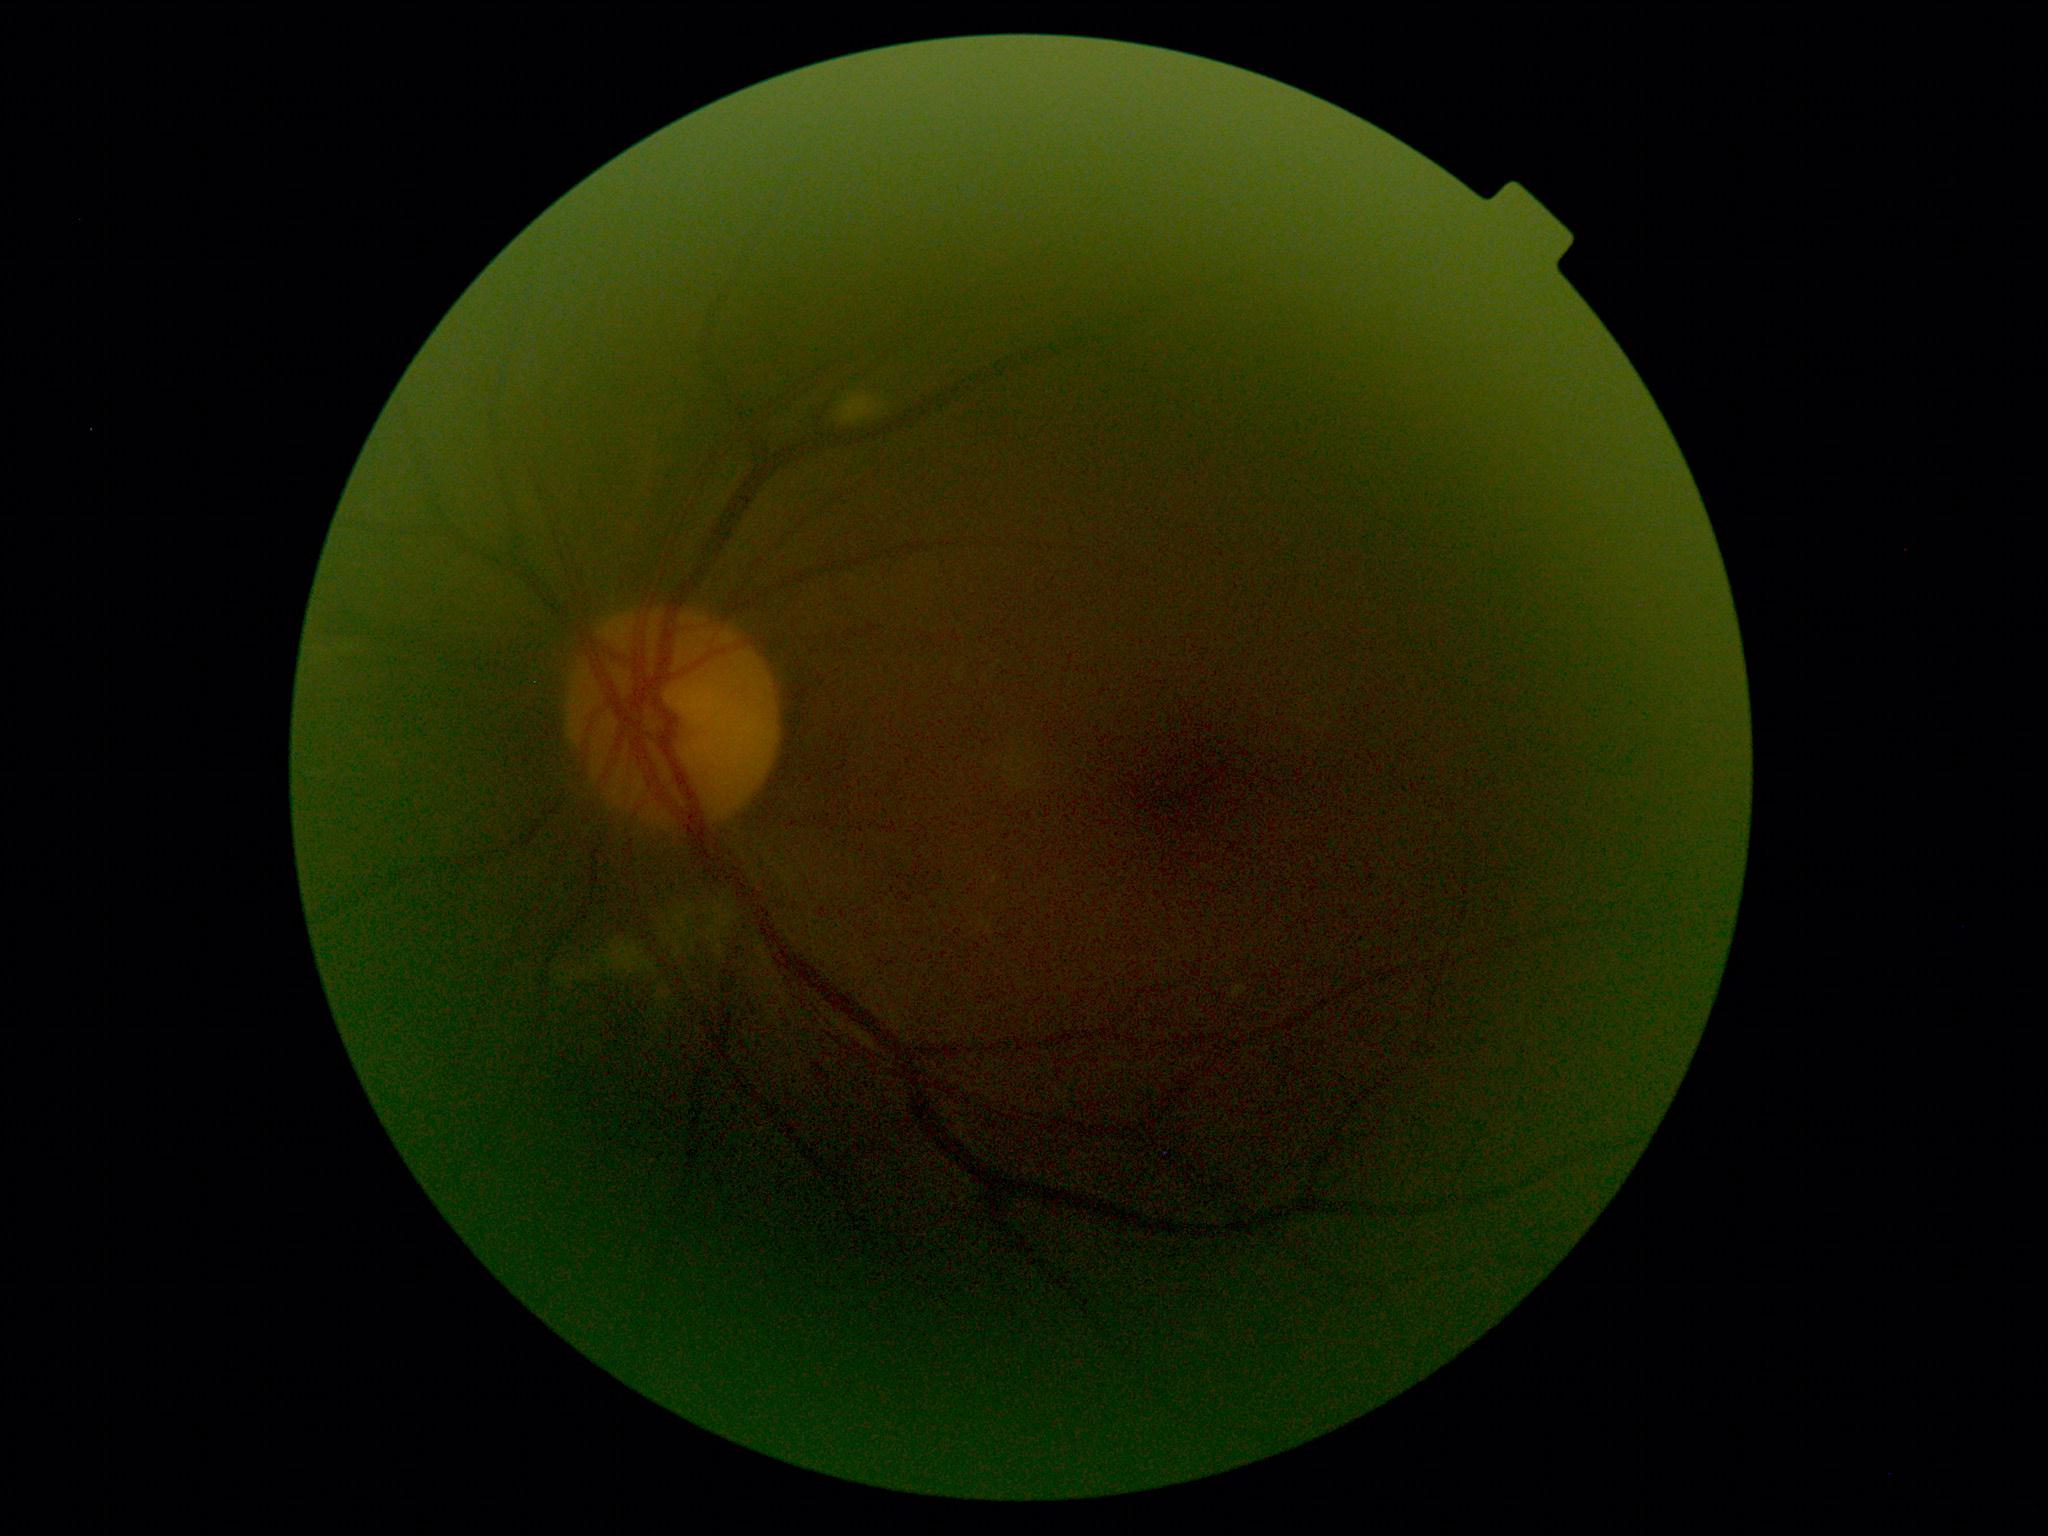
DR severity: 2.